Modified Davis grading
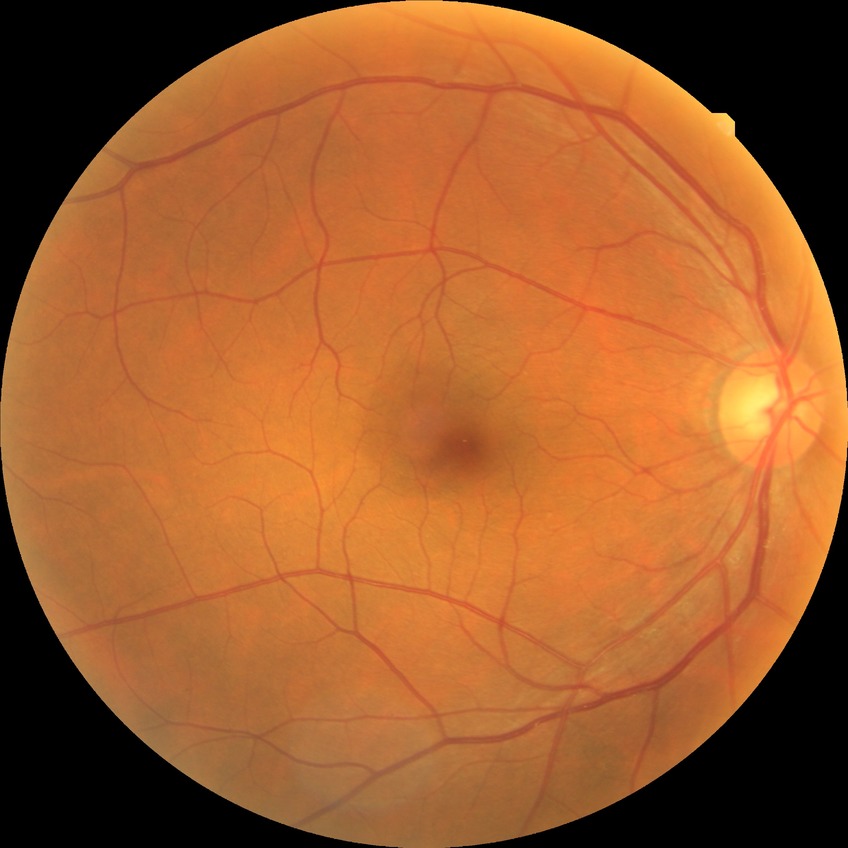 {"davis_grade": "NDR (no diabetic retinopathy)"}